2184x1690px
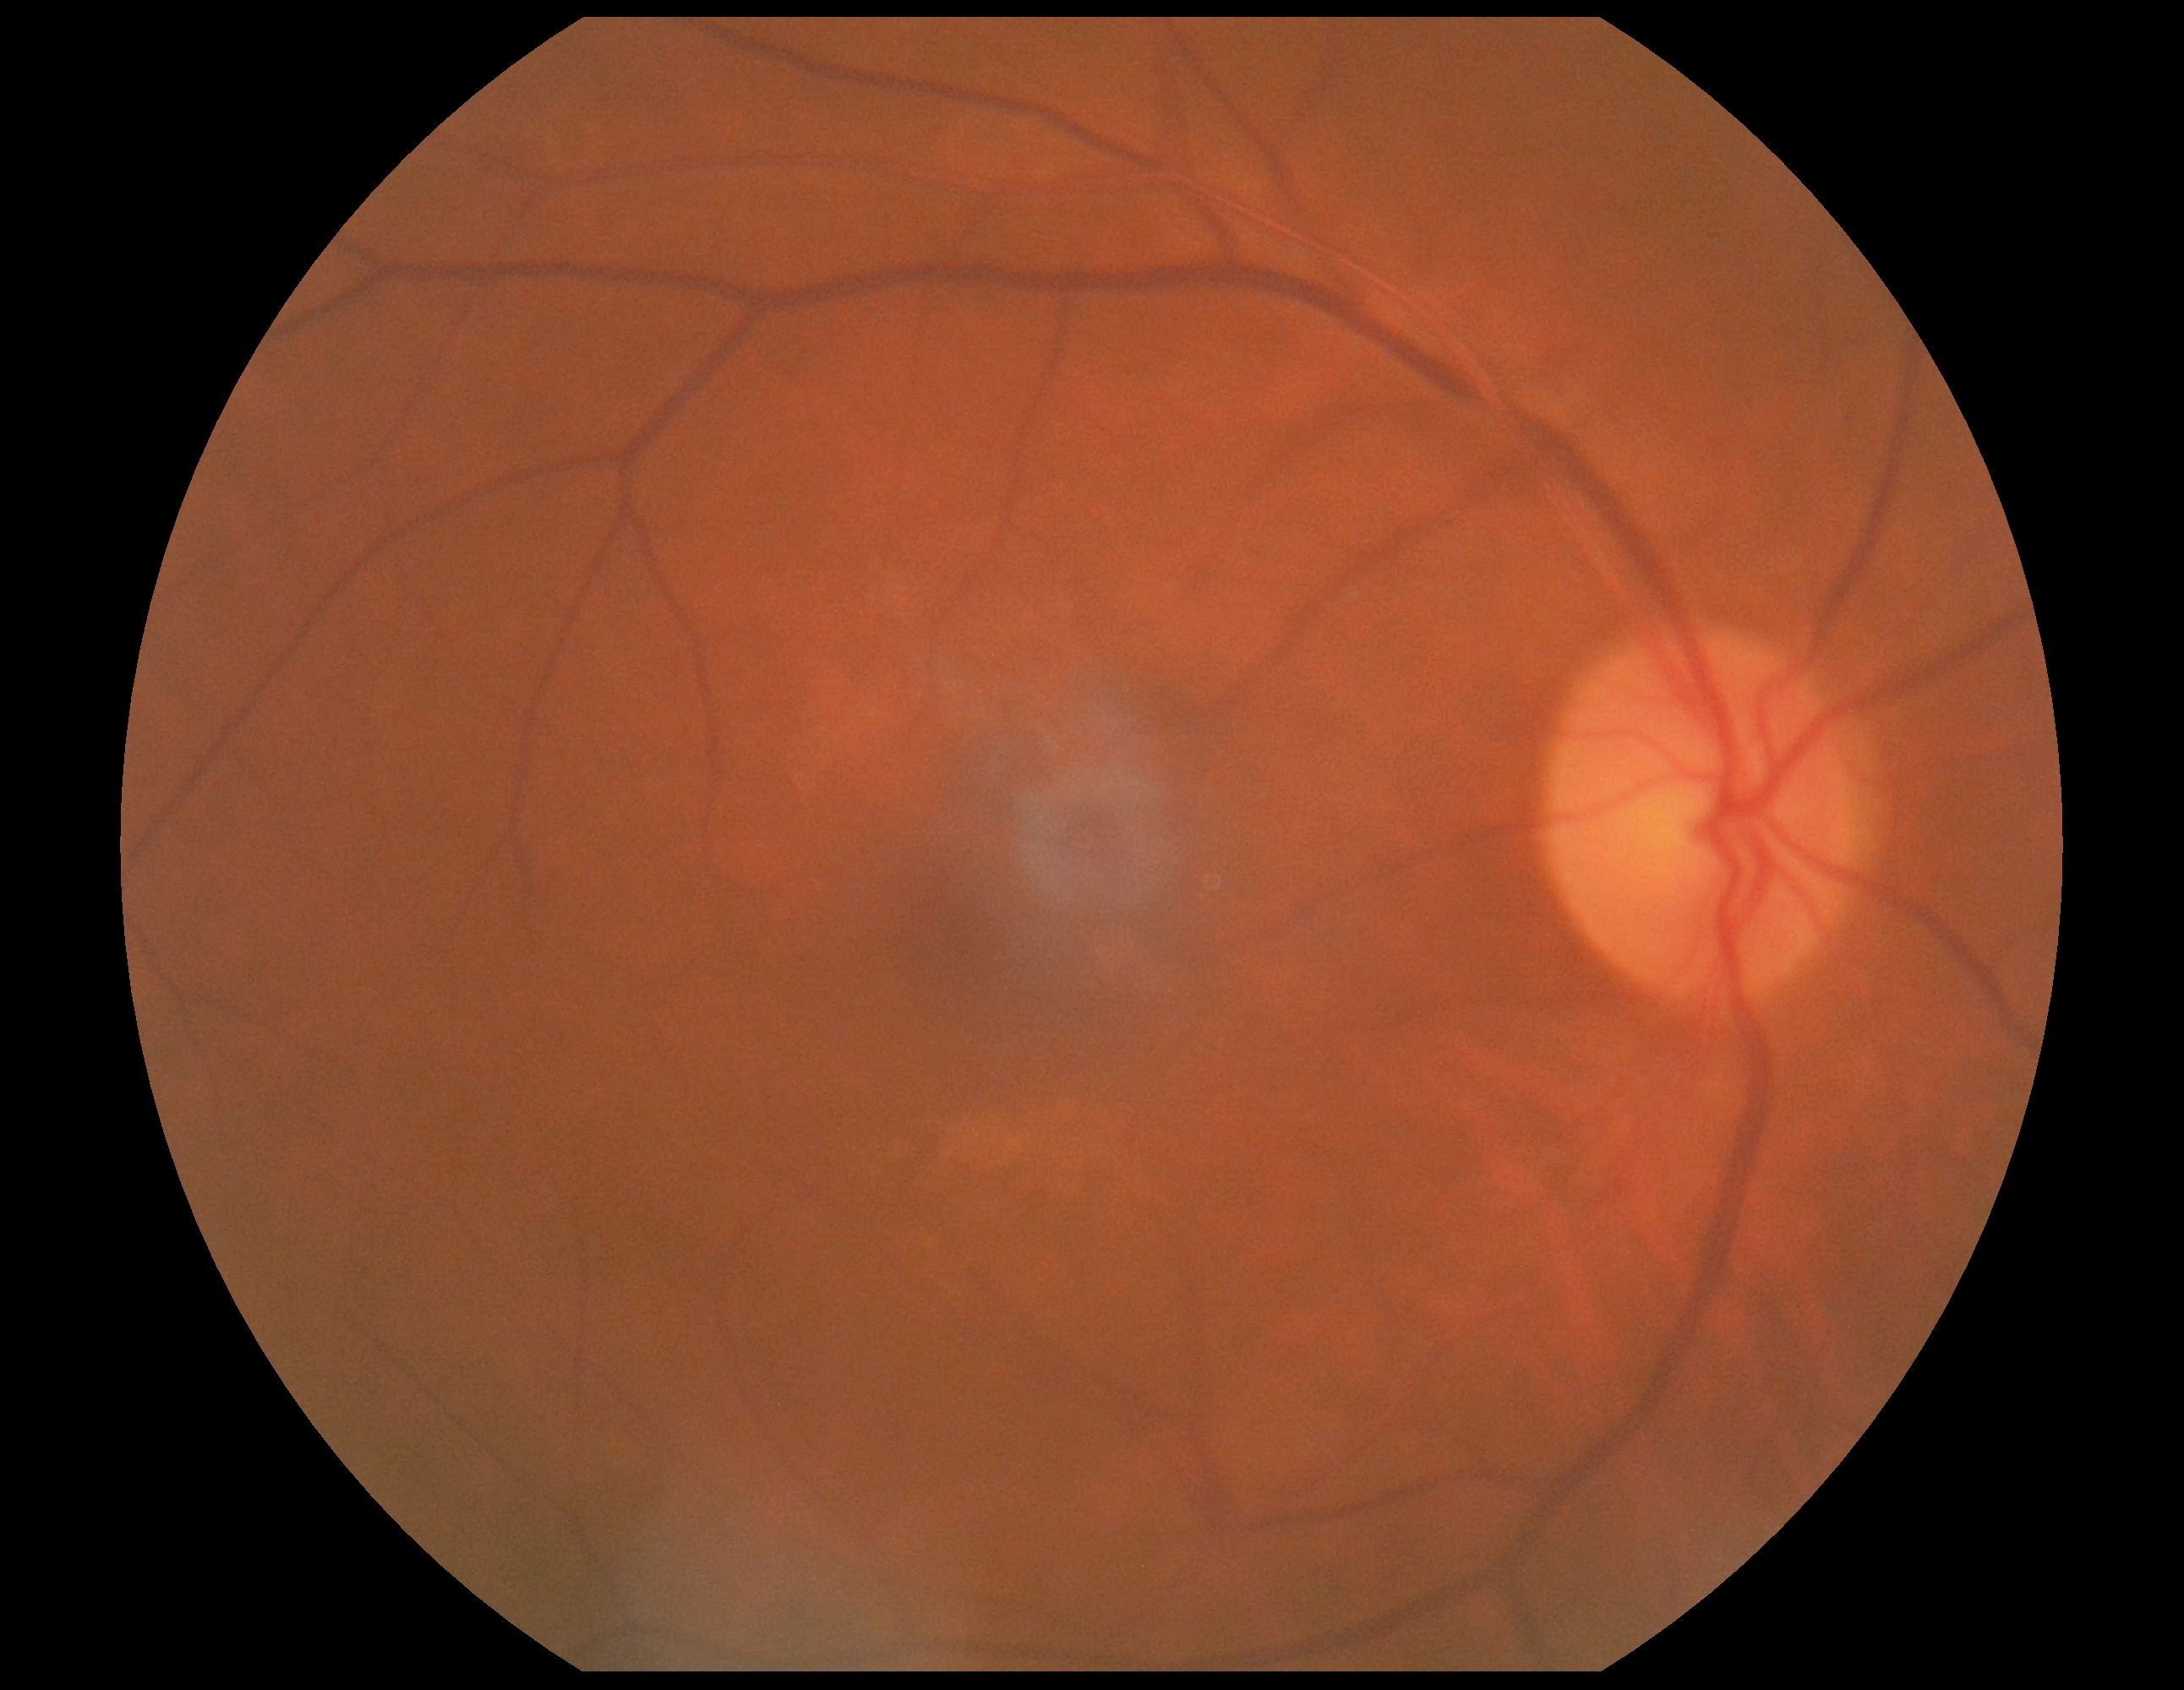
DR grade: 0 (no apparent retinopathy) — no visible signs of diabetic retinopathy